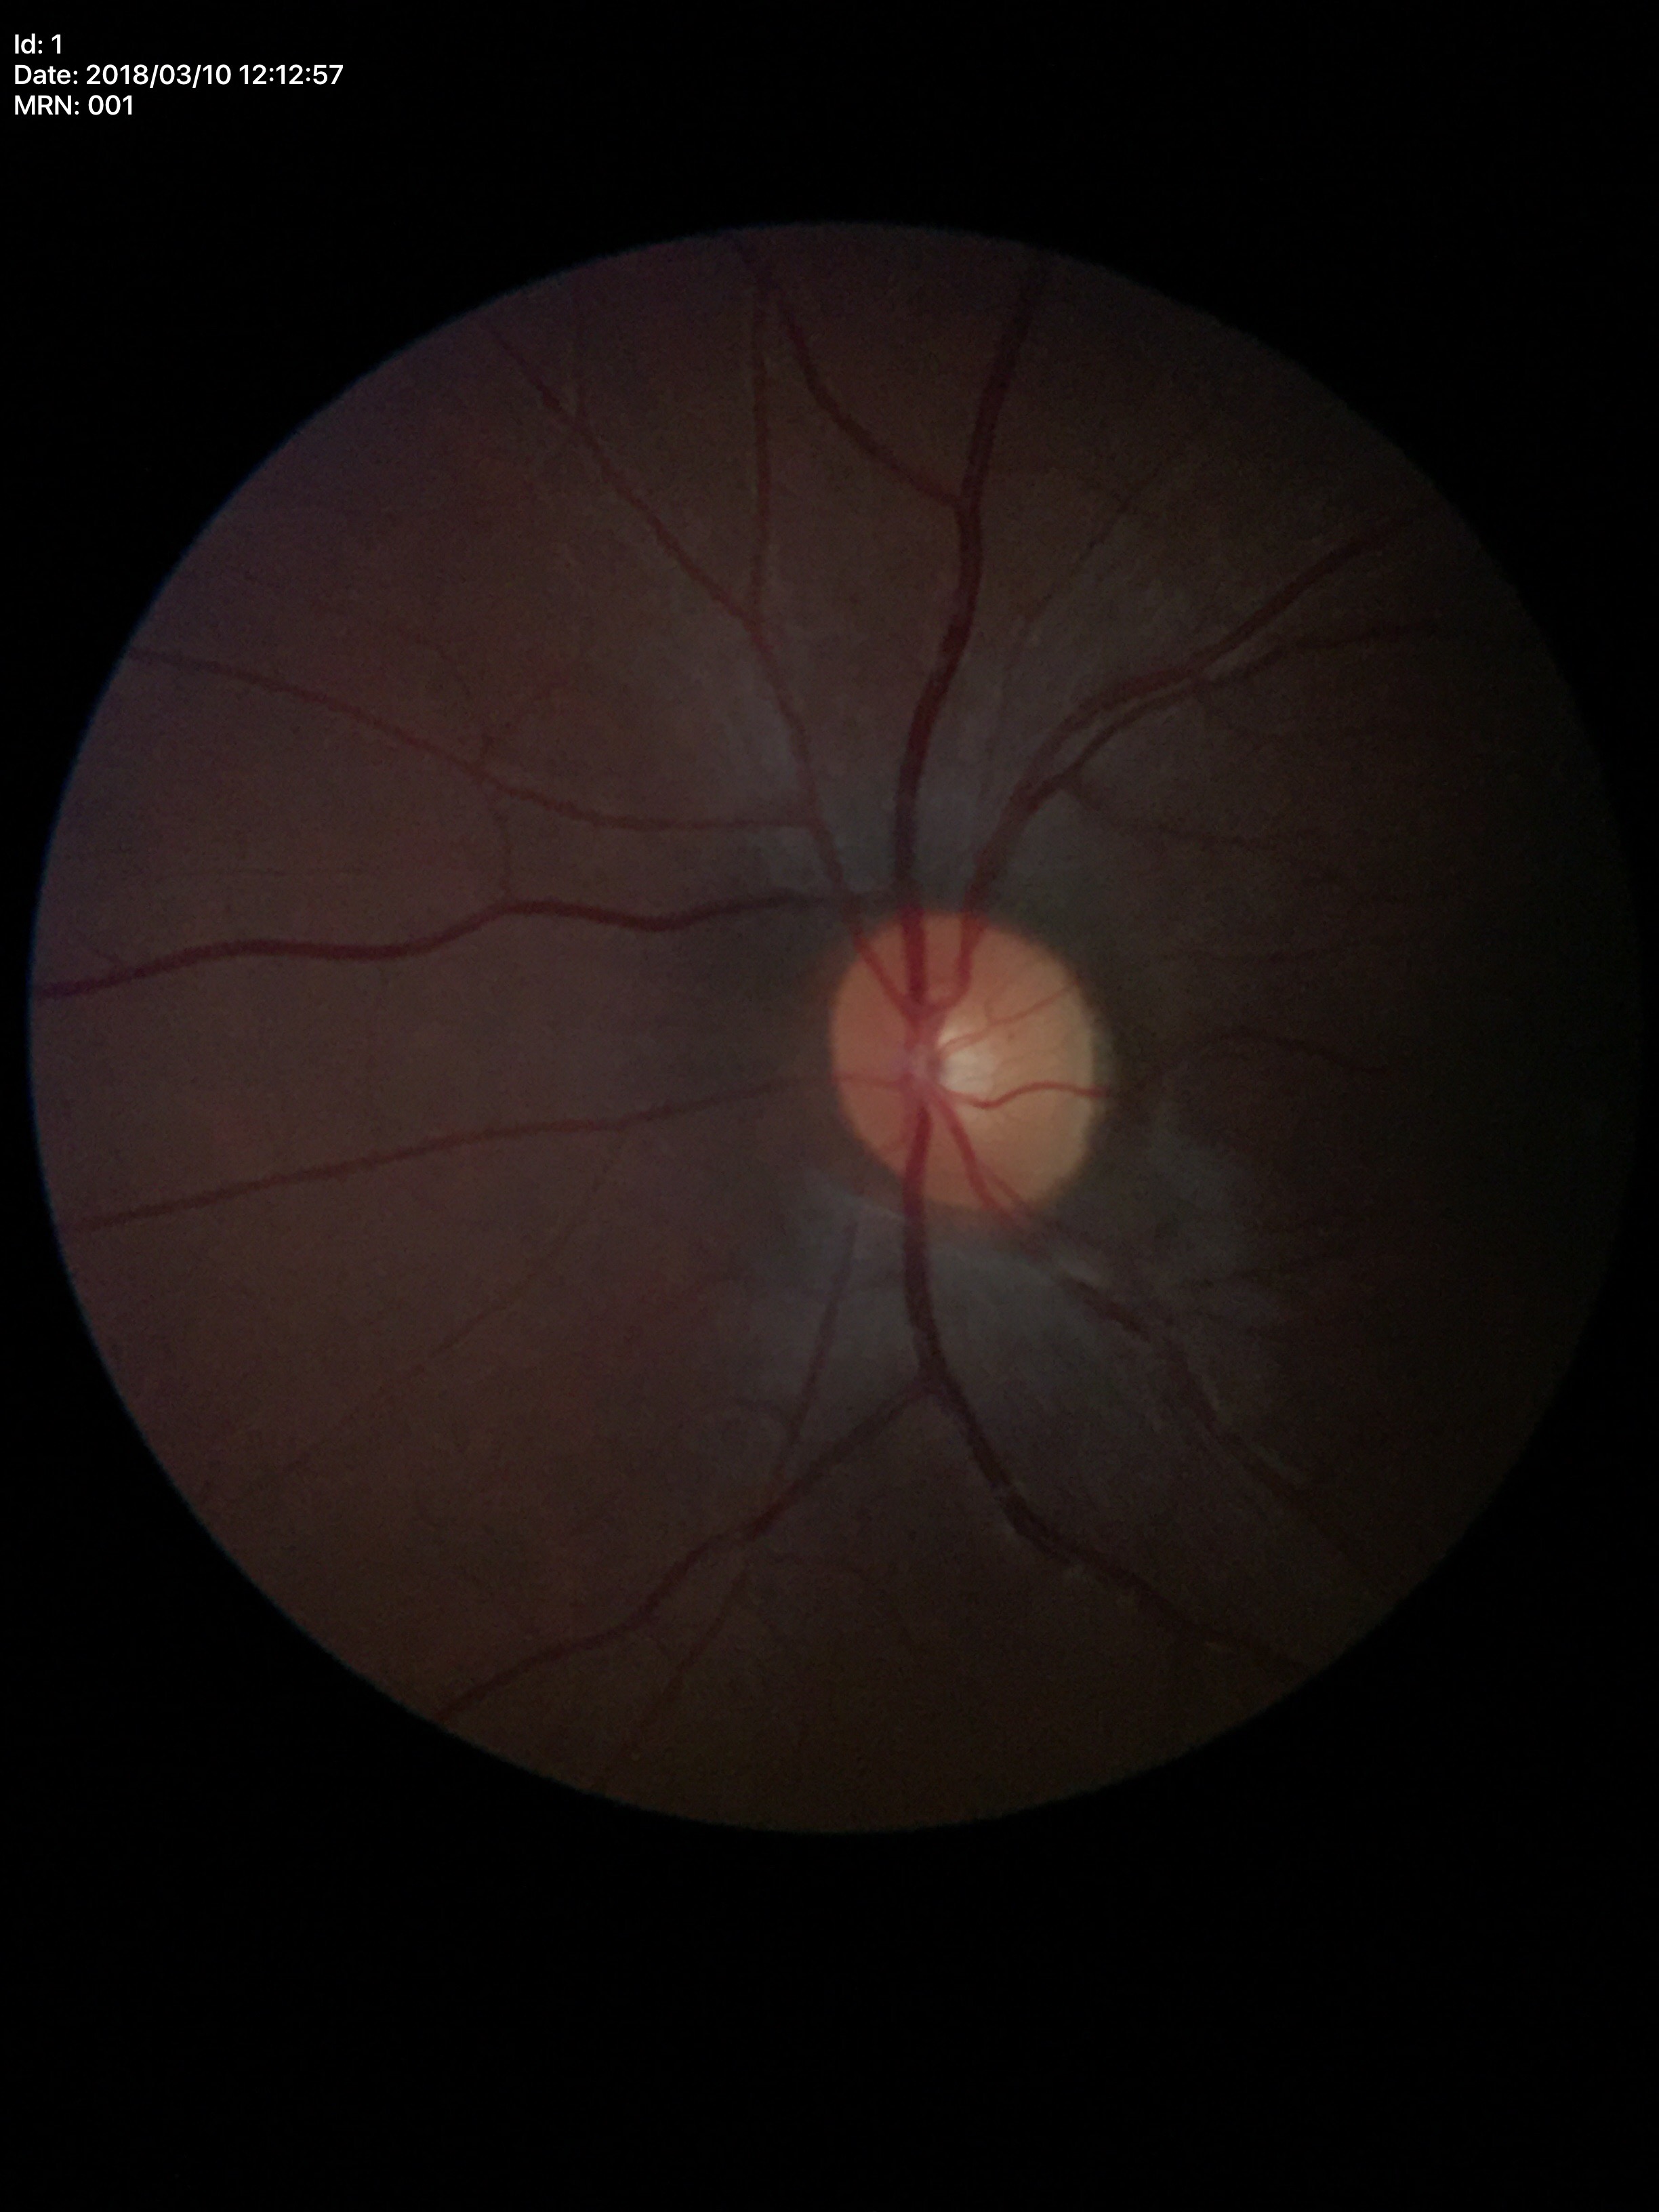 HCDR of 0.46.
Glaucoma assessment: no suspicious findings (unanimous normal call).
VCDR: 0.47.